848x848 · posterior pole color fundus photograph · Davis DR grading:
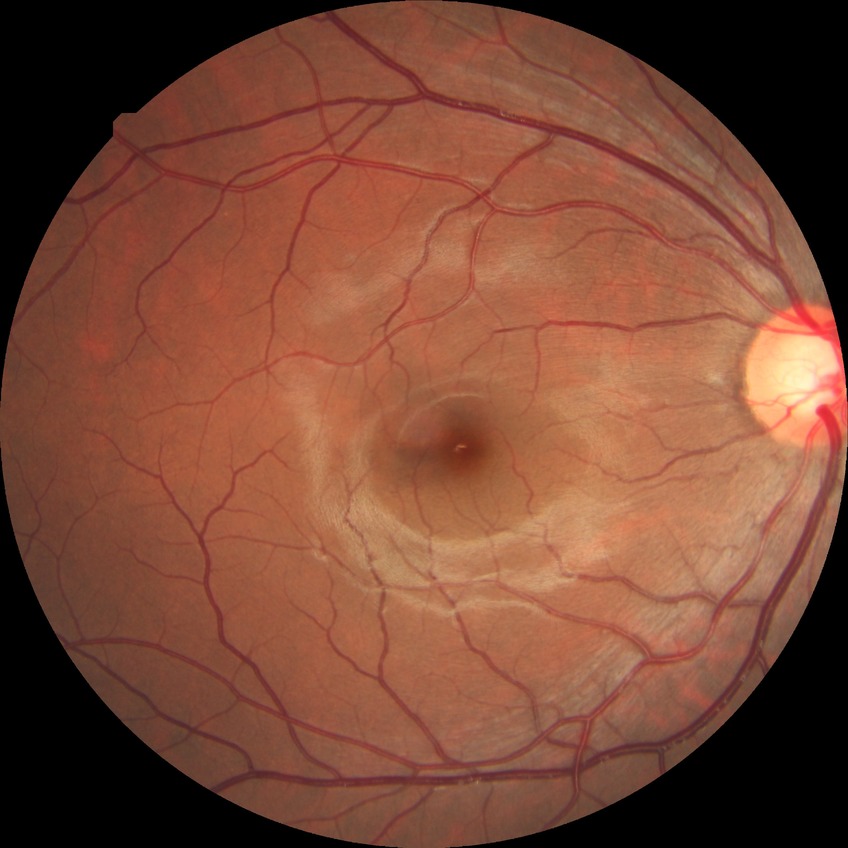

Diabetic retinopathy stage: no diabetic retinopathy.